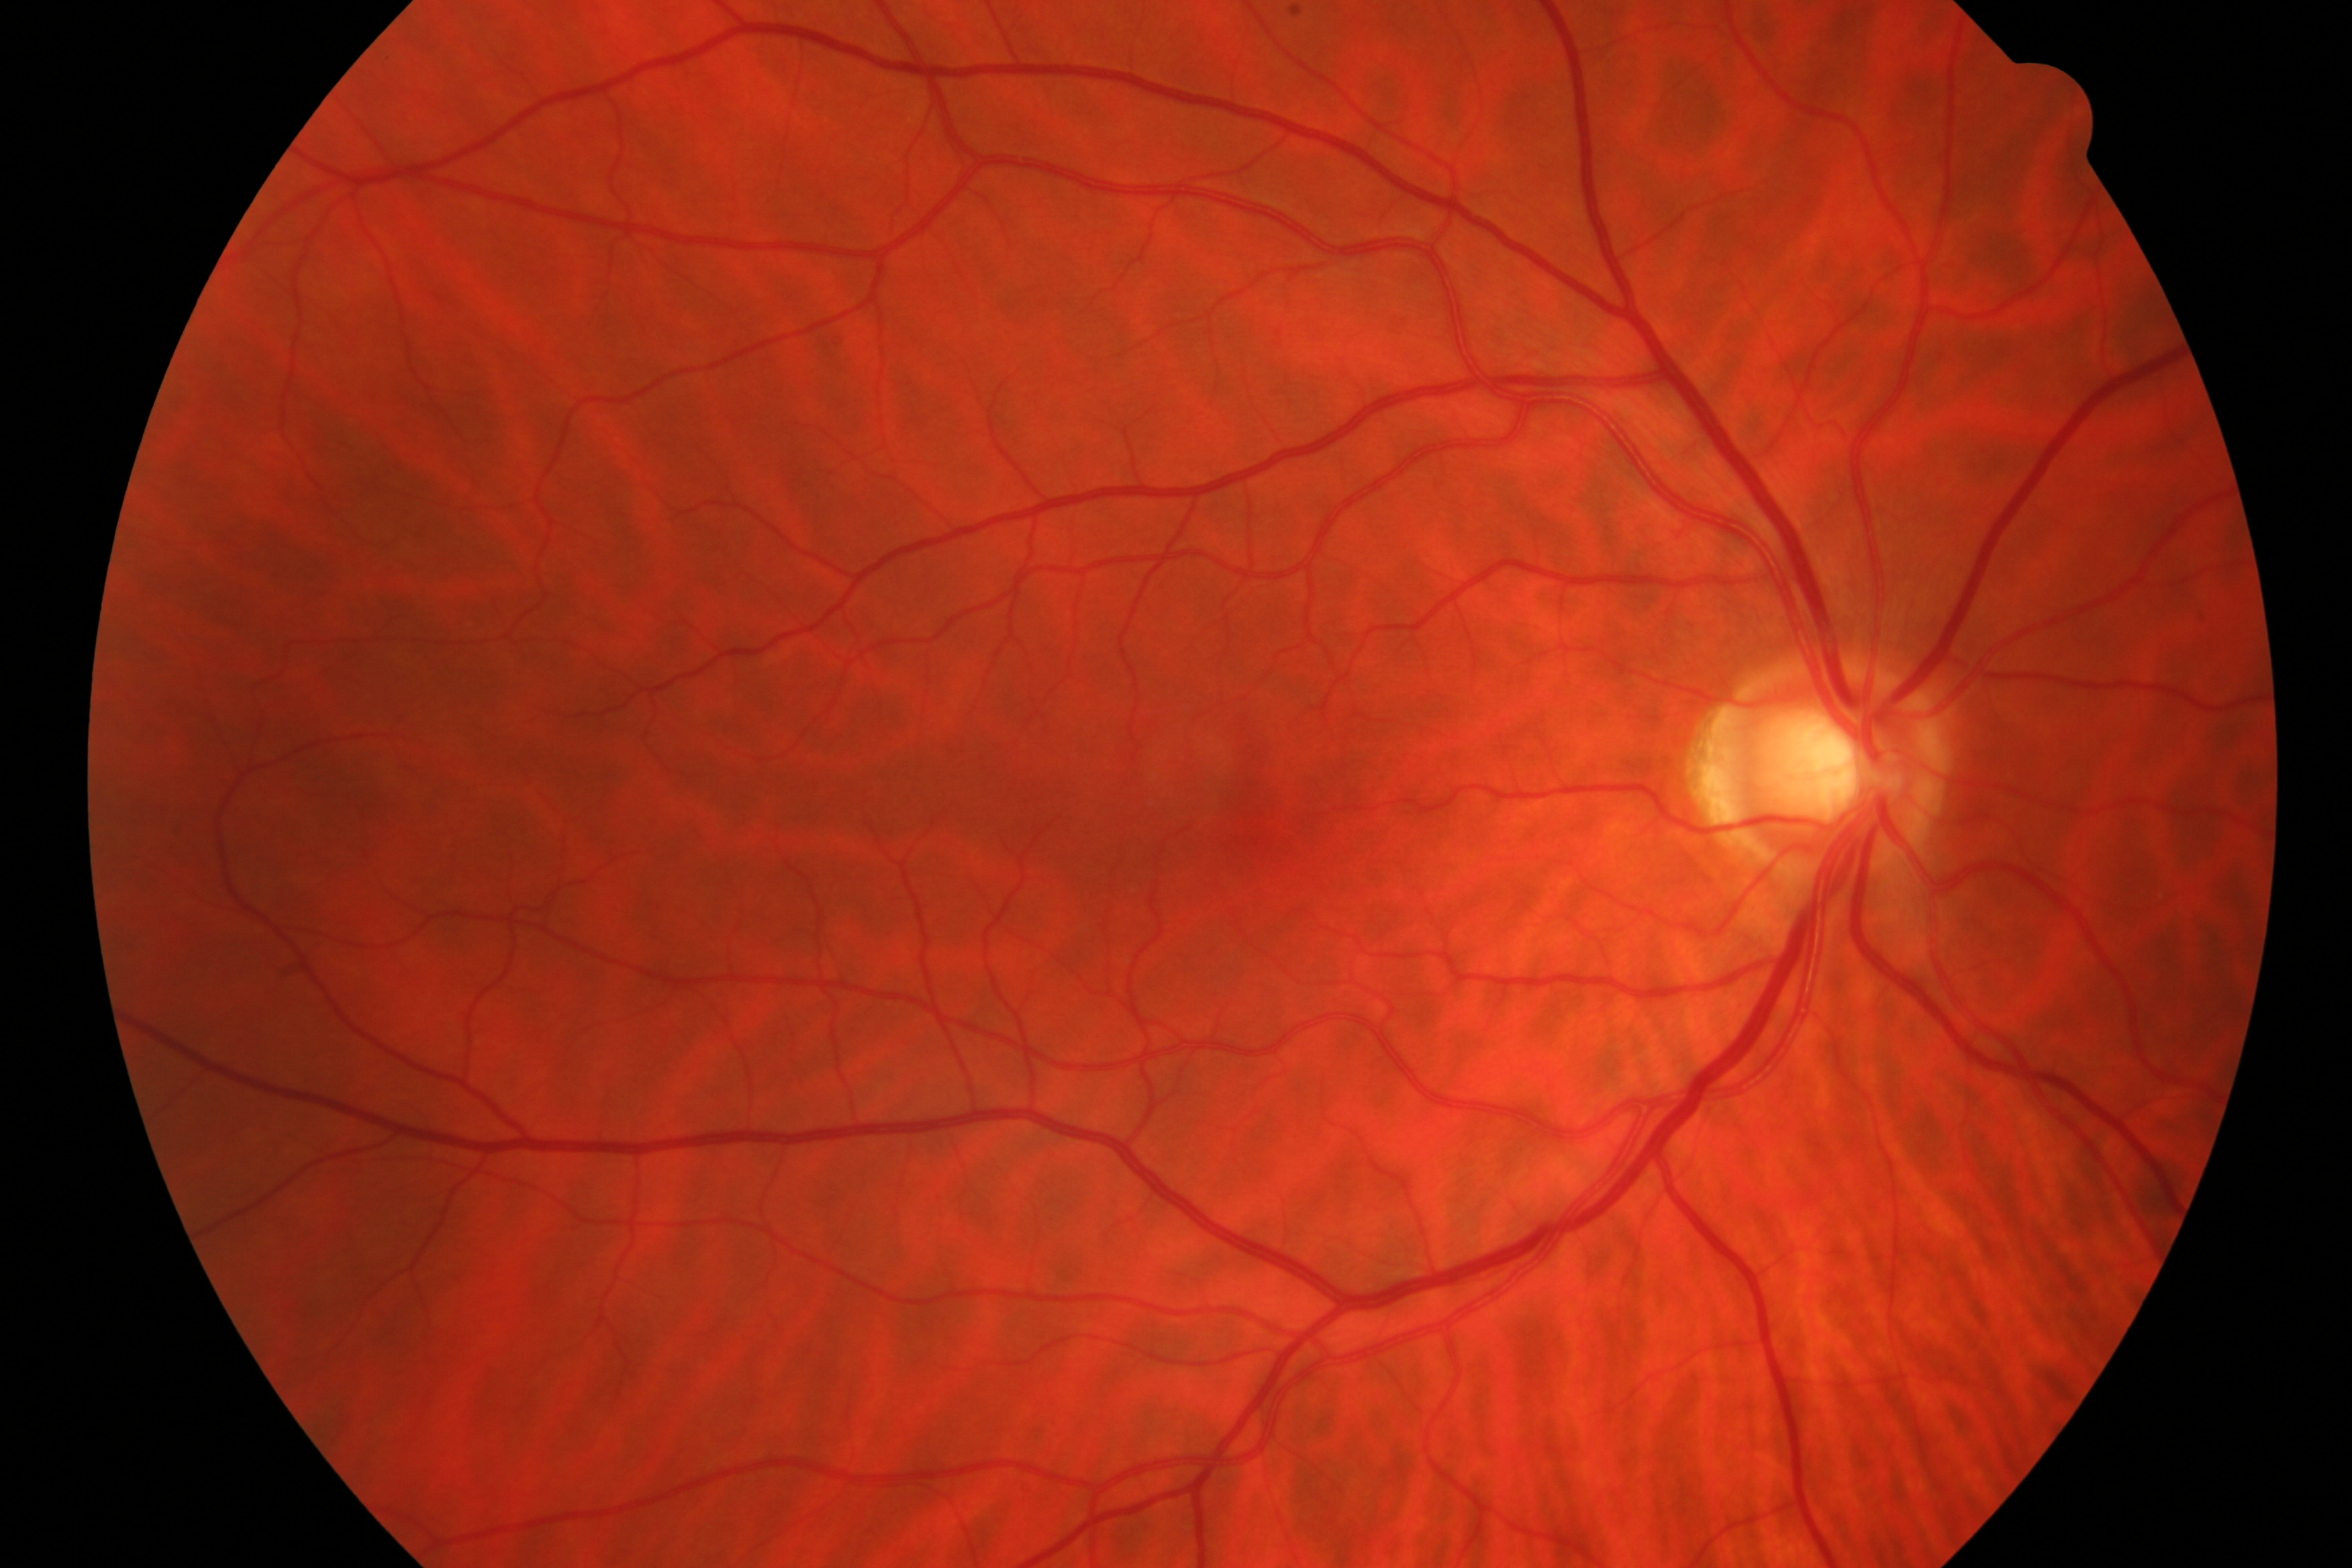

Color fundus photograph showing glaucomatous changes.